CFP. 512x512 — 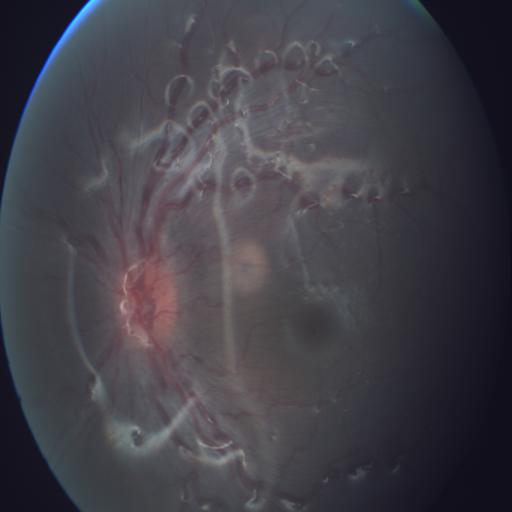
Two abnormalities. Demonstrates tortuous vessels (TV) & optic disc edema (ODE).